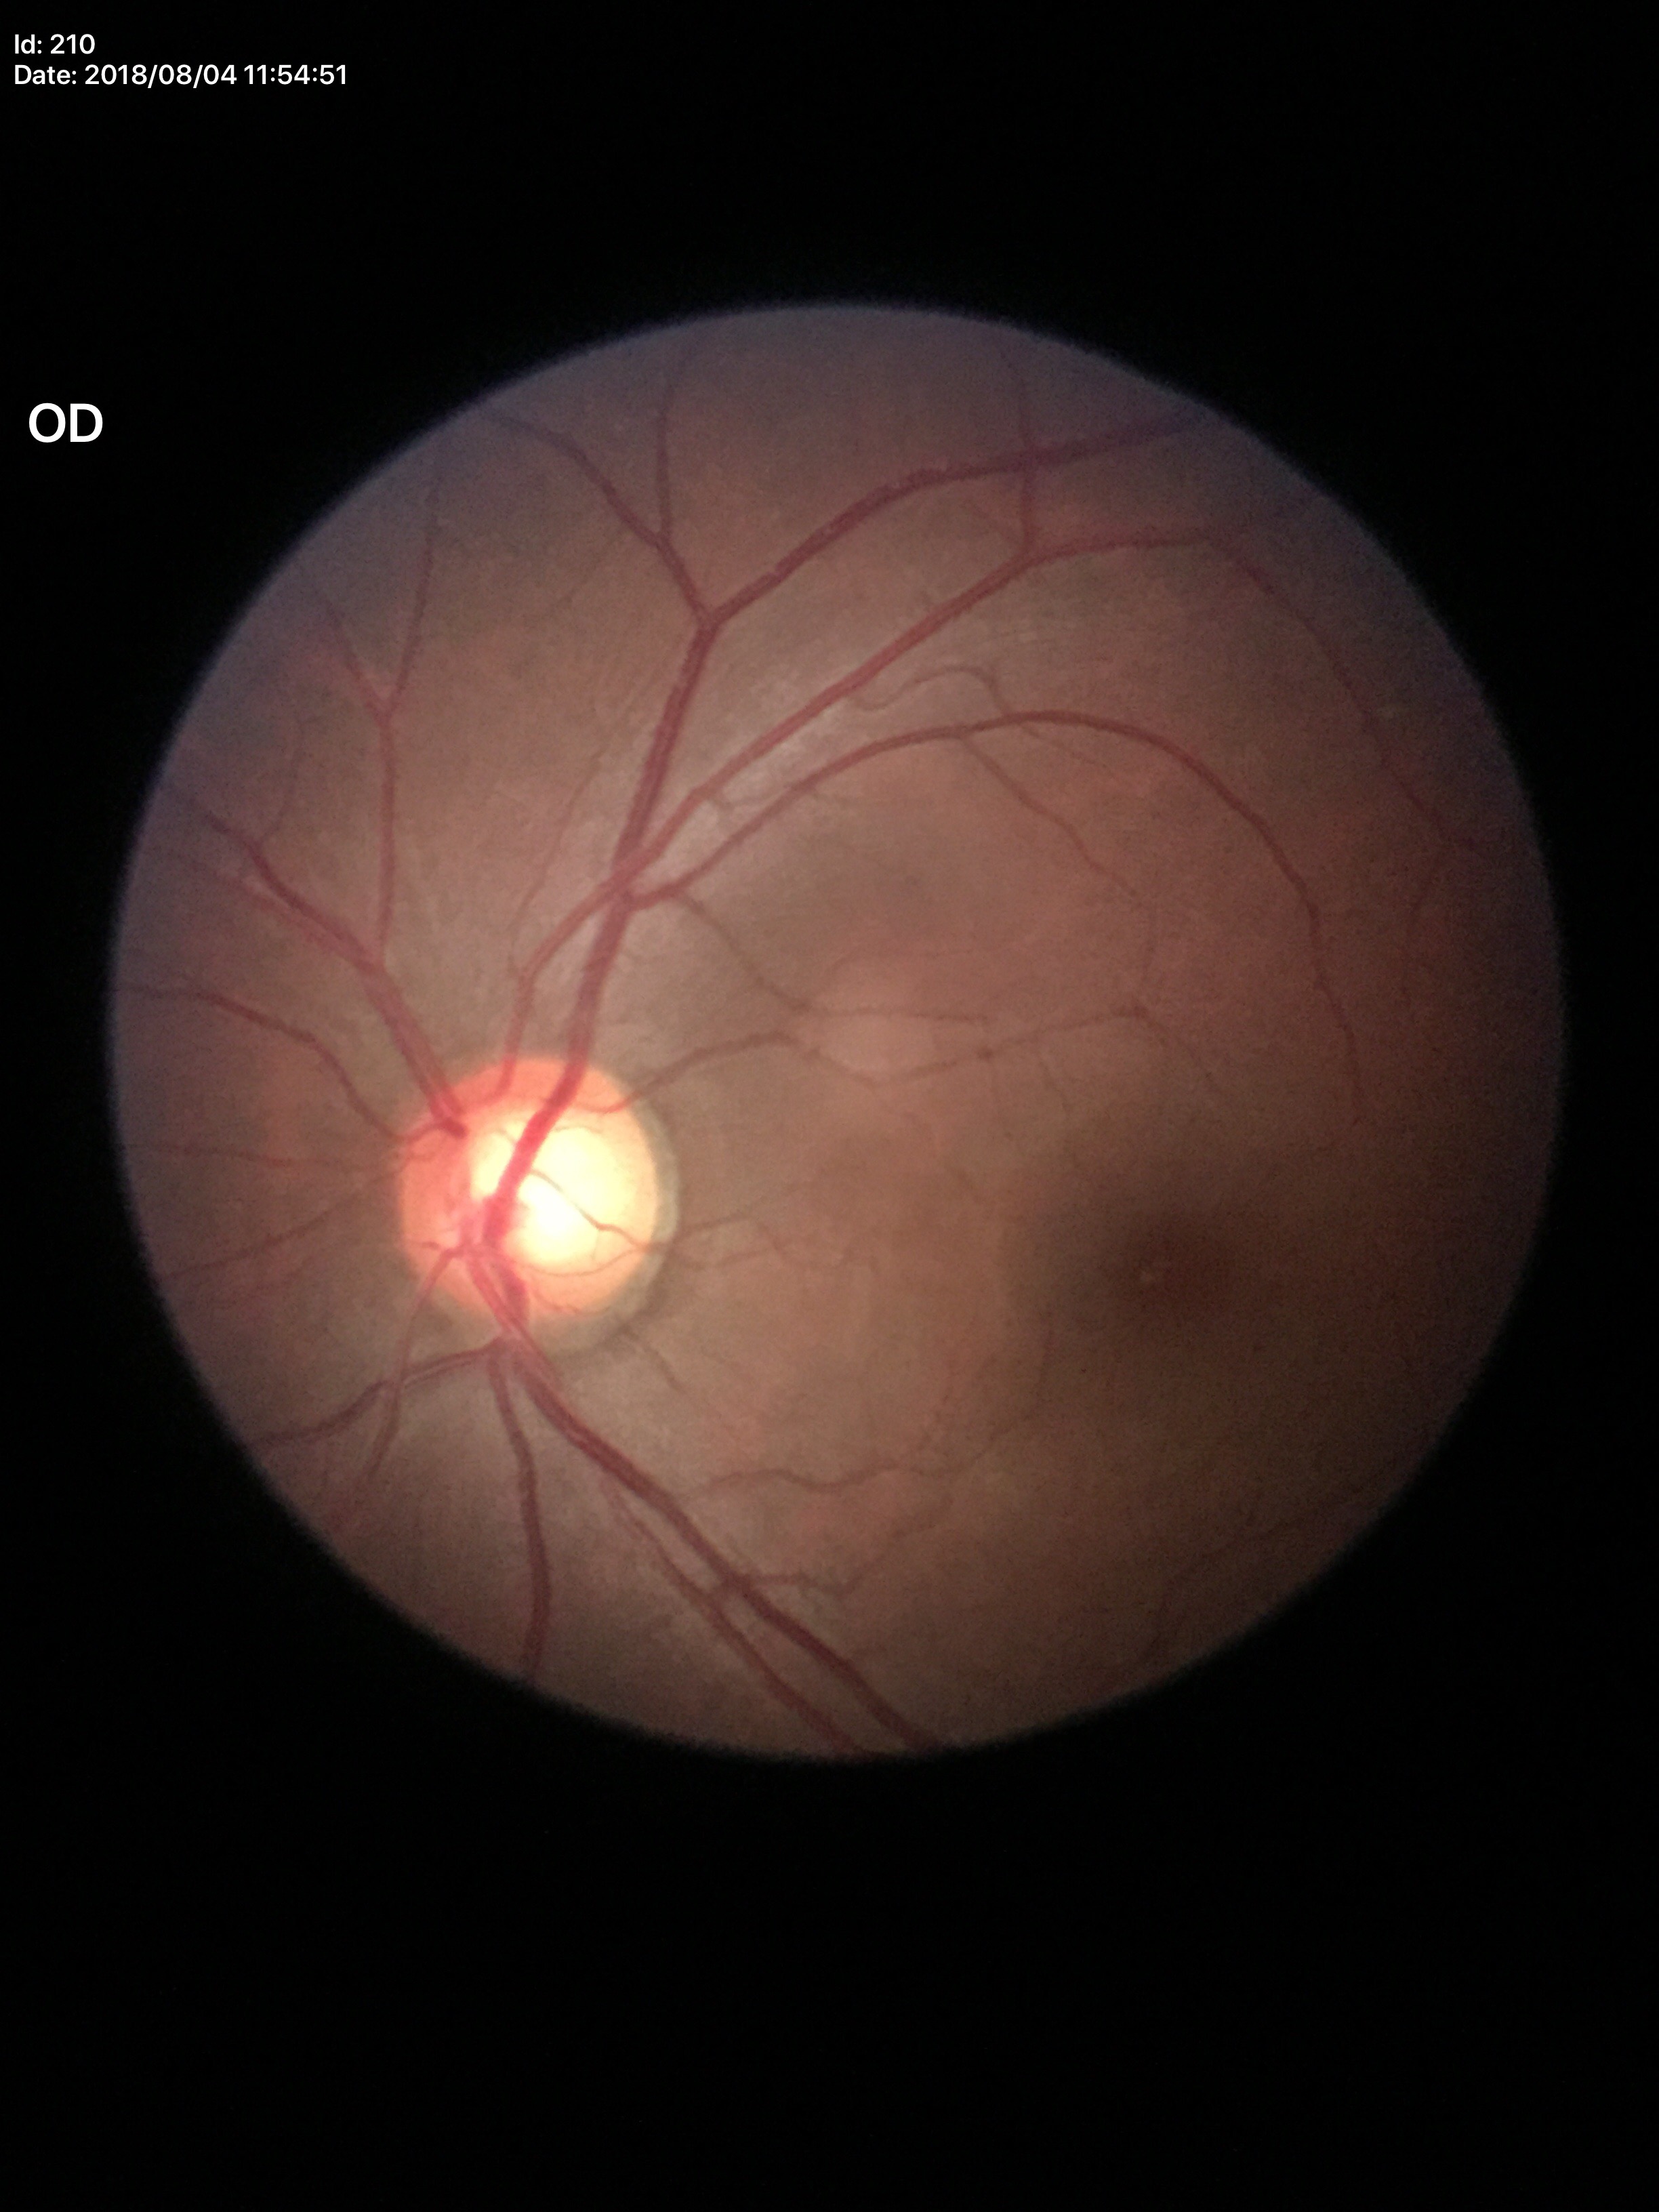 VCDR=0.64; Glaucoma screening=suspect